Posterior pole view. Camera: Topcon TRC-50DX. Image size 2228x1652. 50-degree field of view.
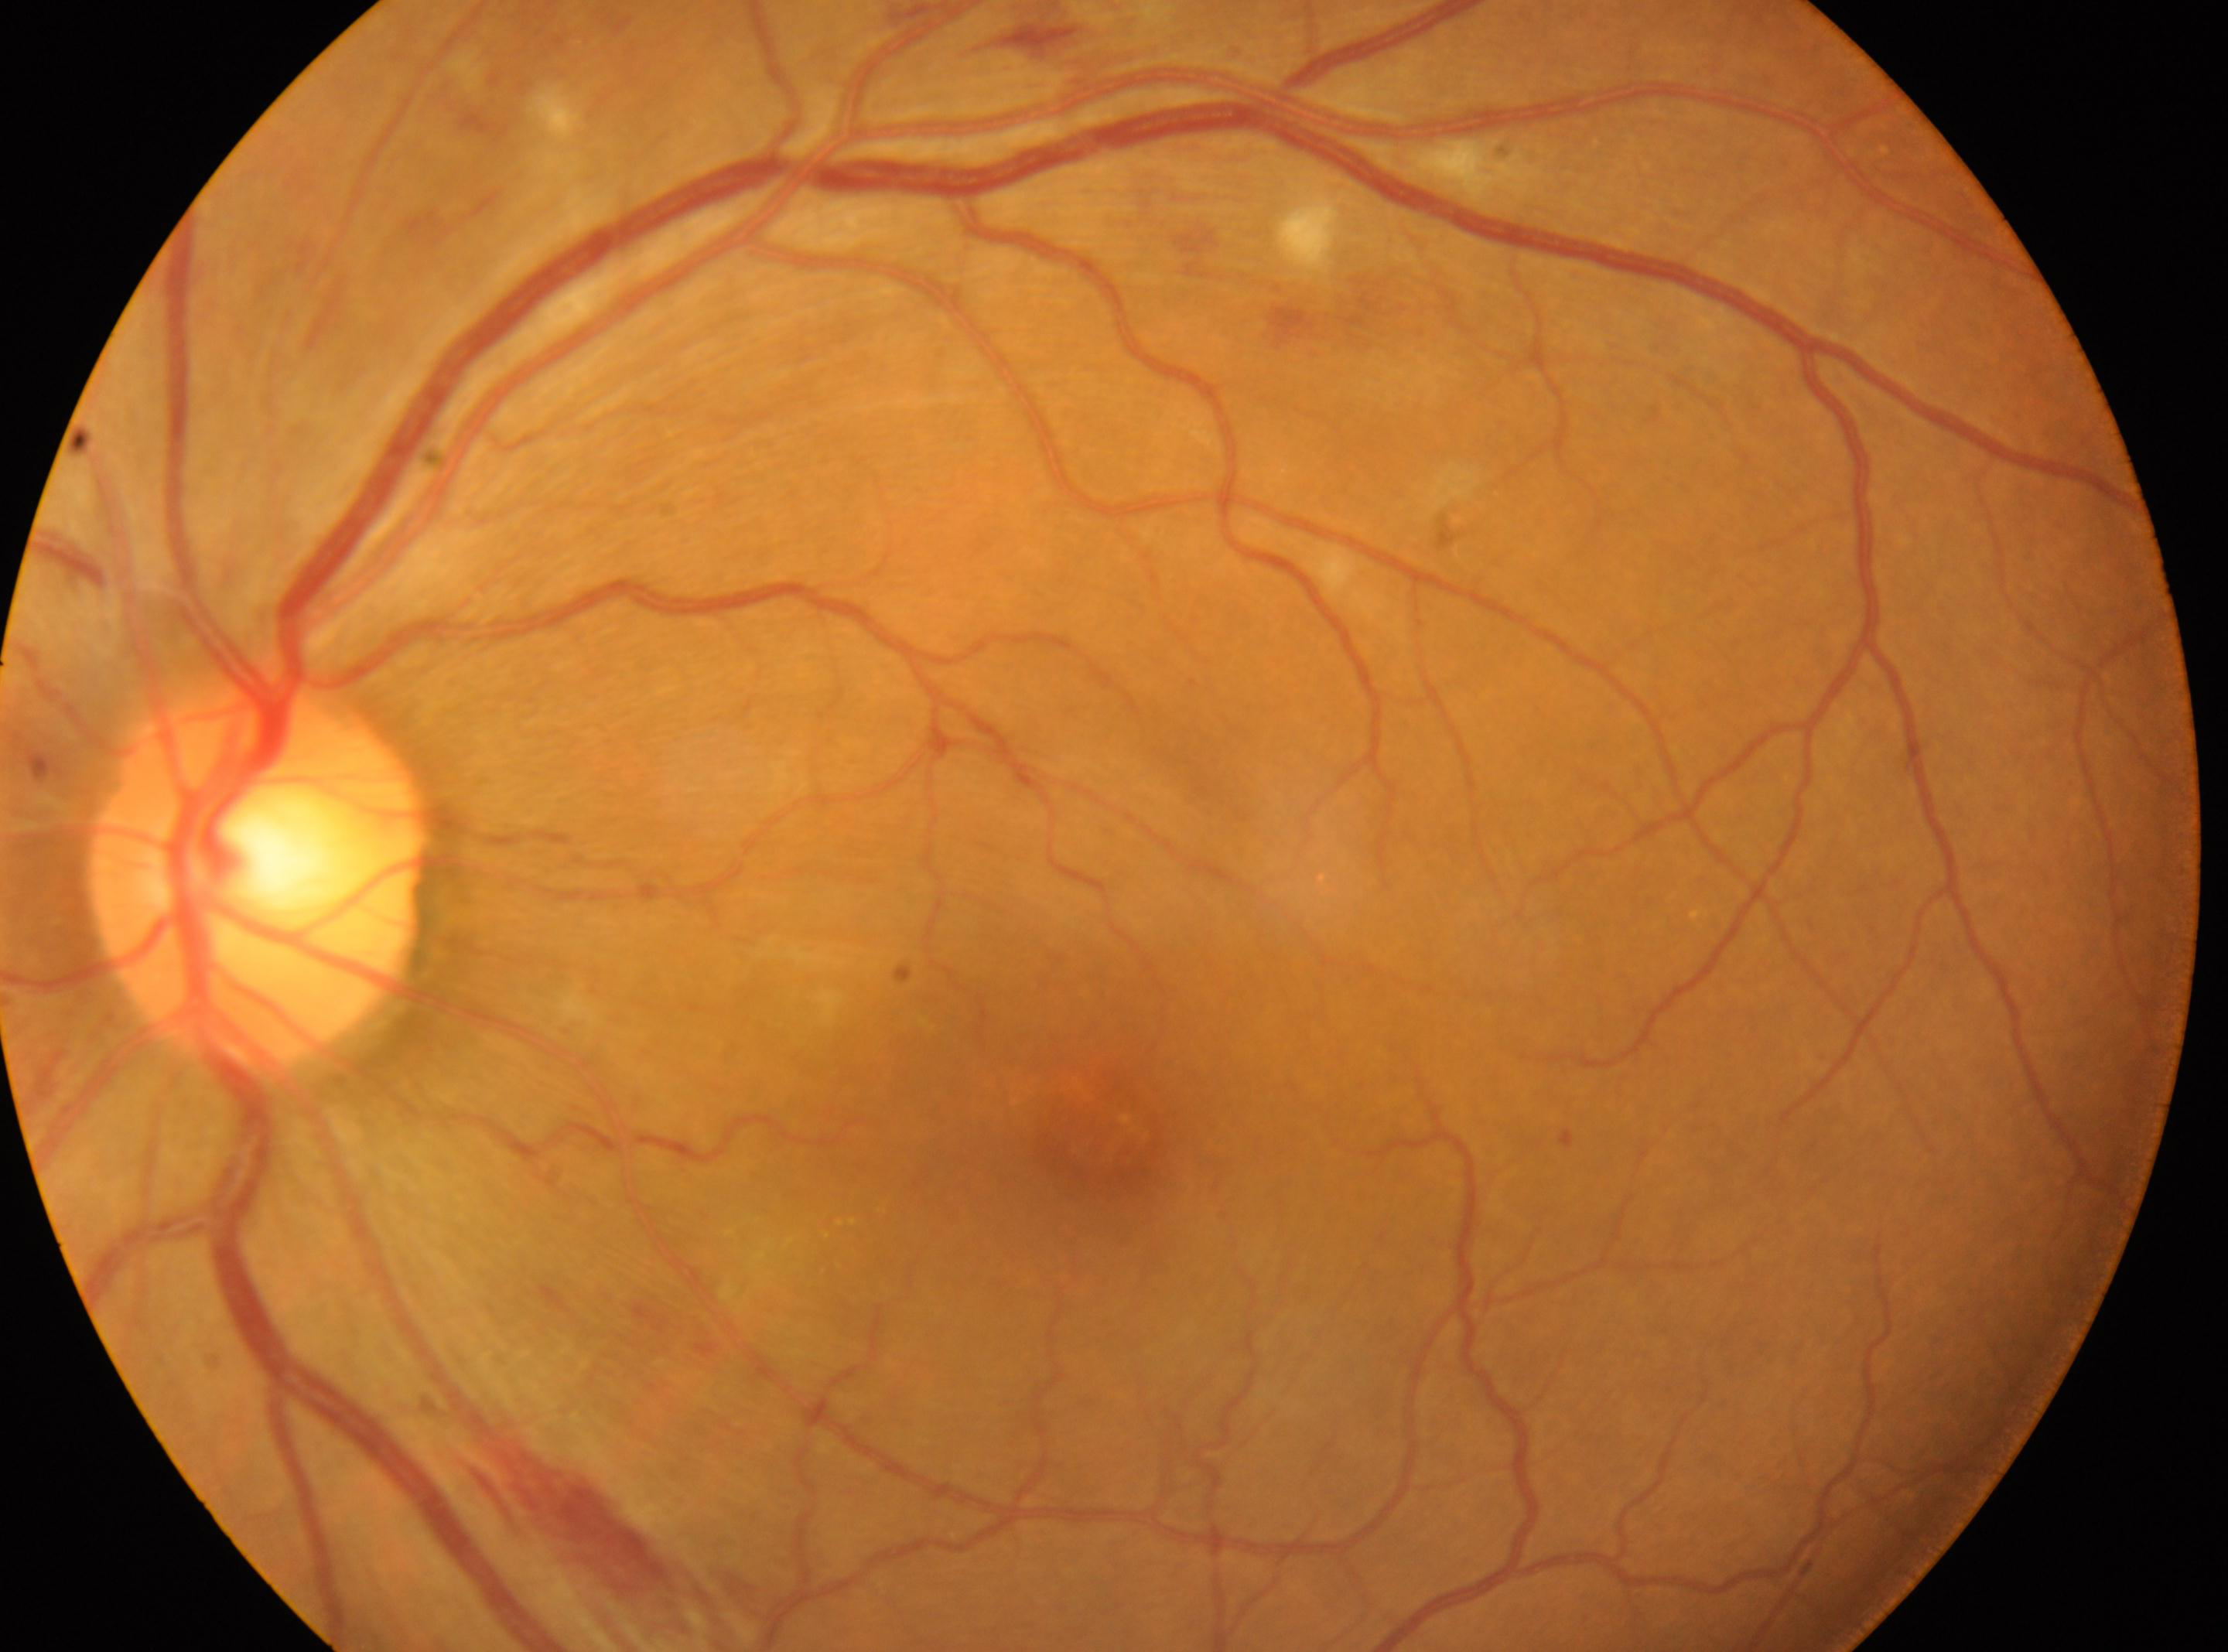
diabetic retinopathy (DR) = grade 2 (moderate NPDR) | DR class = non-proliferative diabetic retinopathy | laterality = left eye | foveal center = (x: 1102, y: 1143) | optic disk = (x: 258, y: 875).